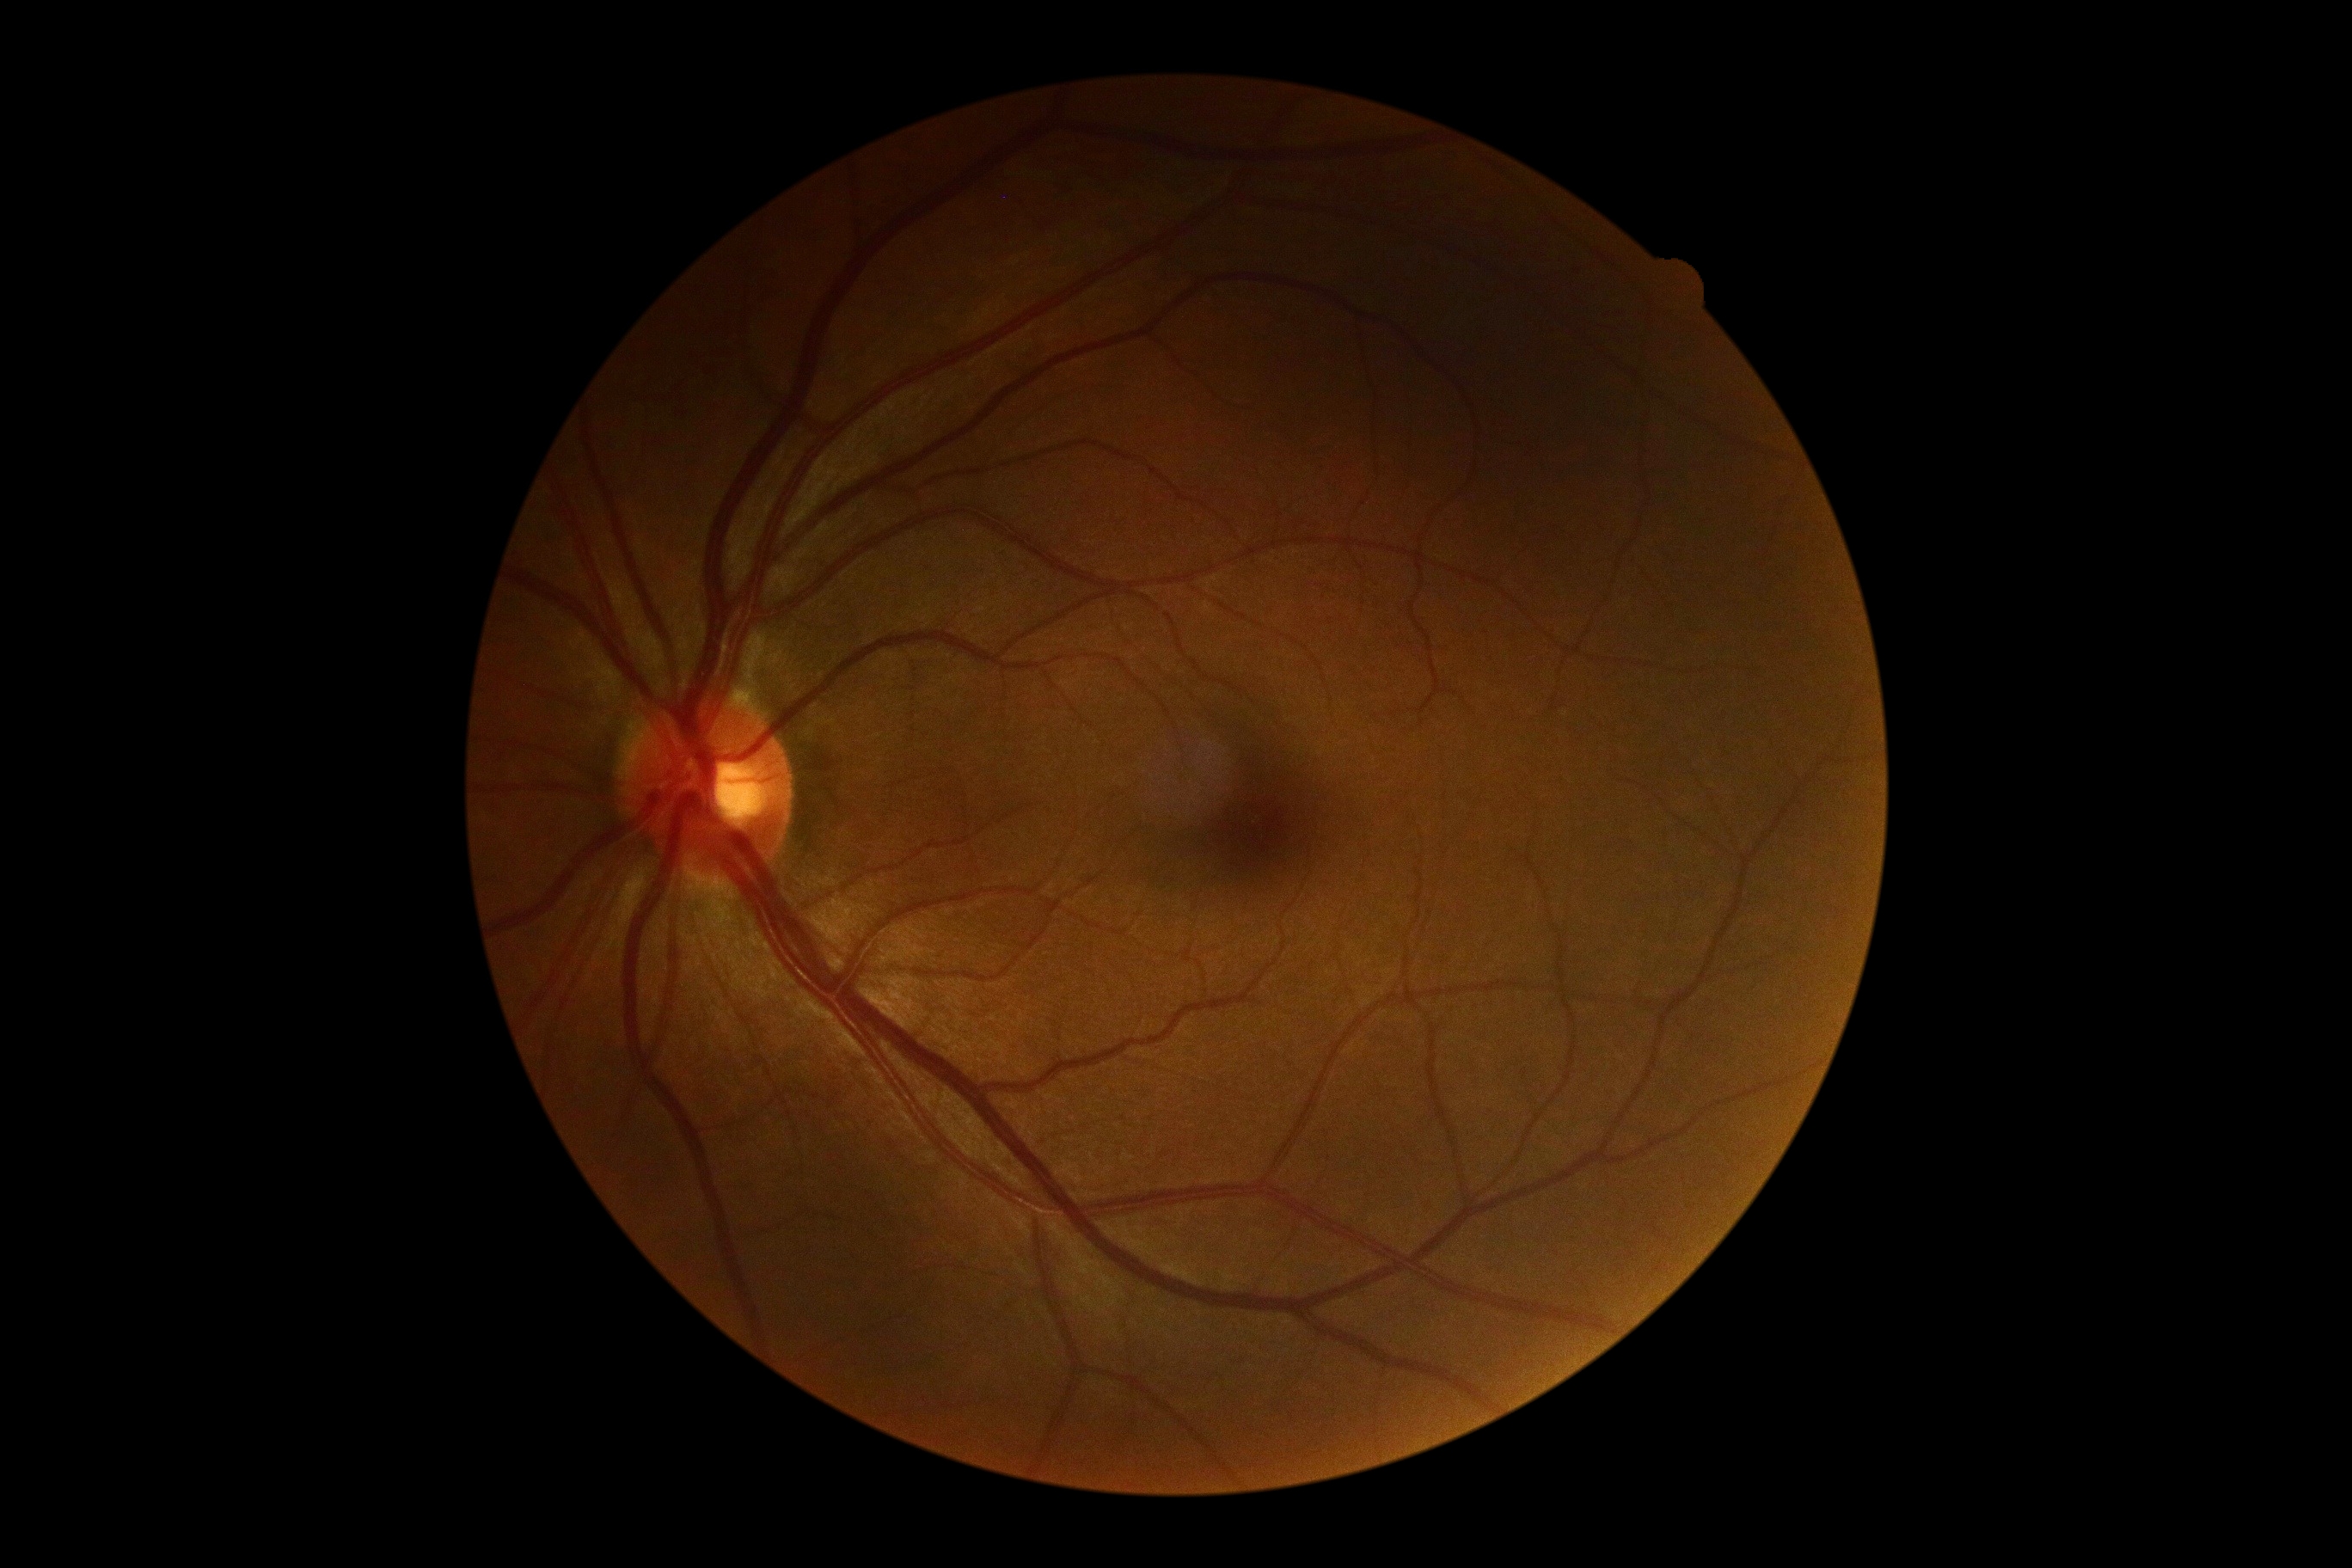 DR impression=negative for DR; diabetic retinopathy grade=no apparent retinopathy (0) — no visible signs of diabetic retinopathy.